1932x1932: 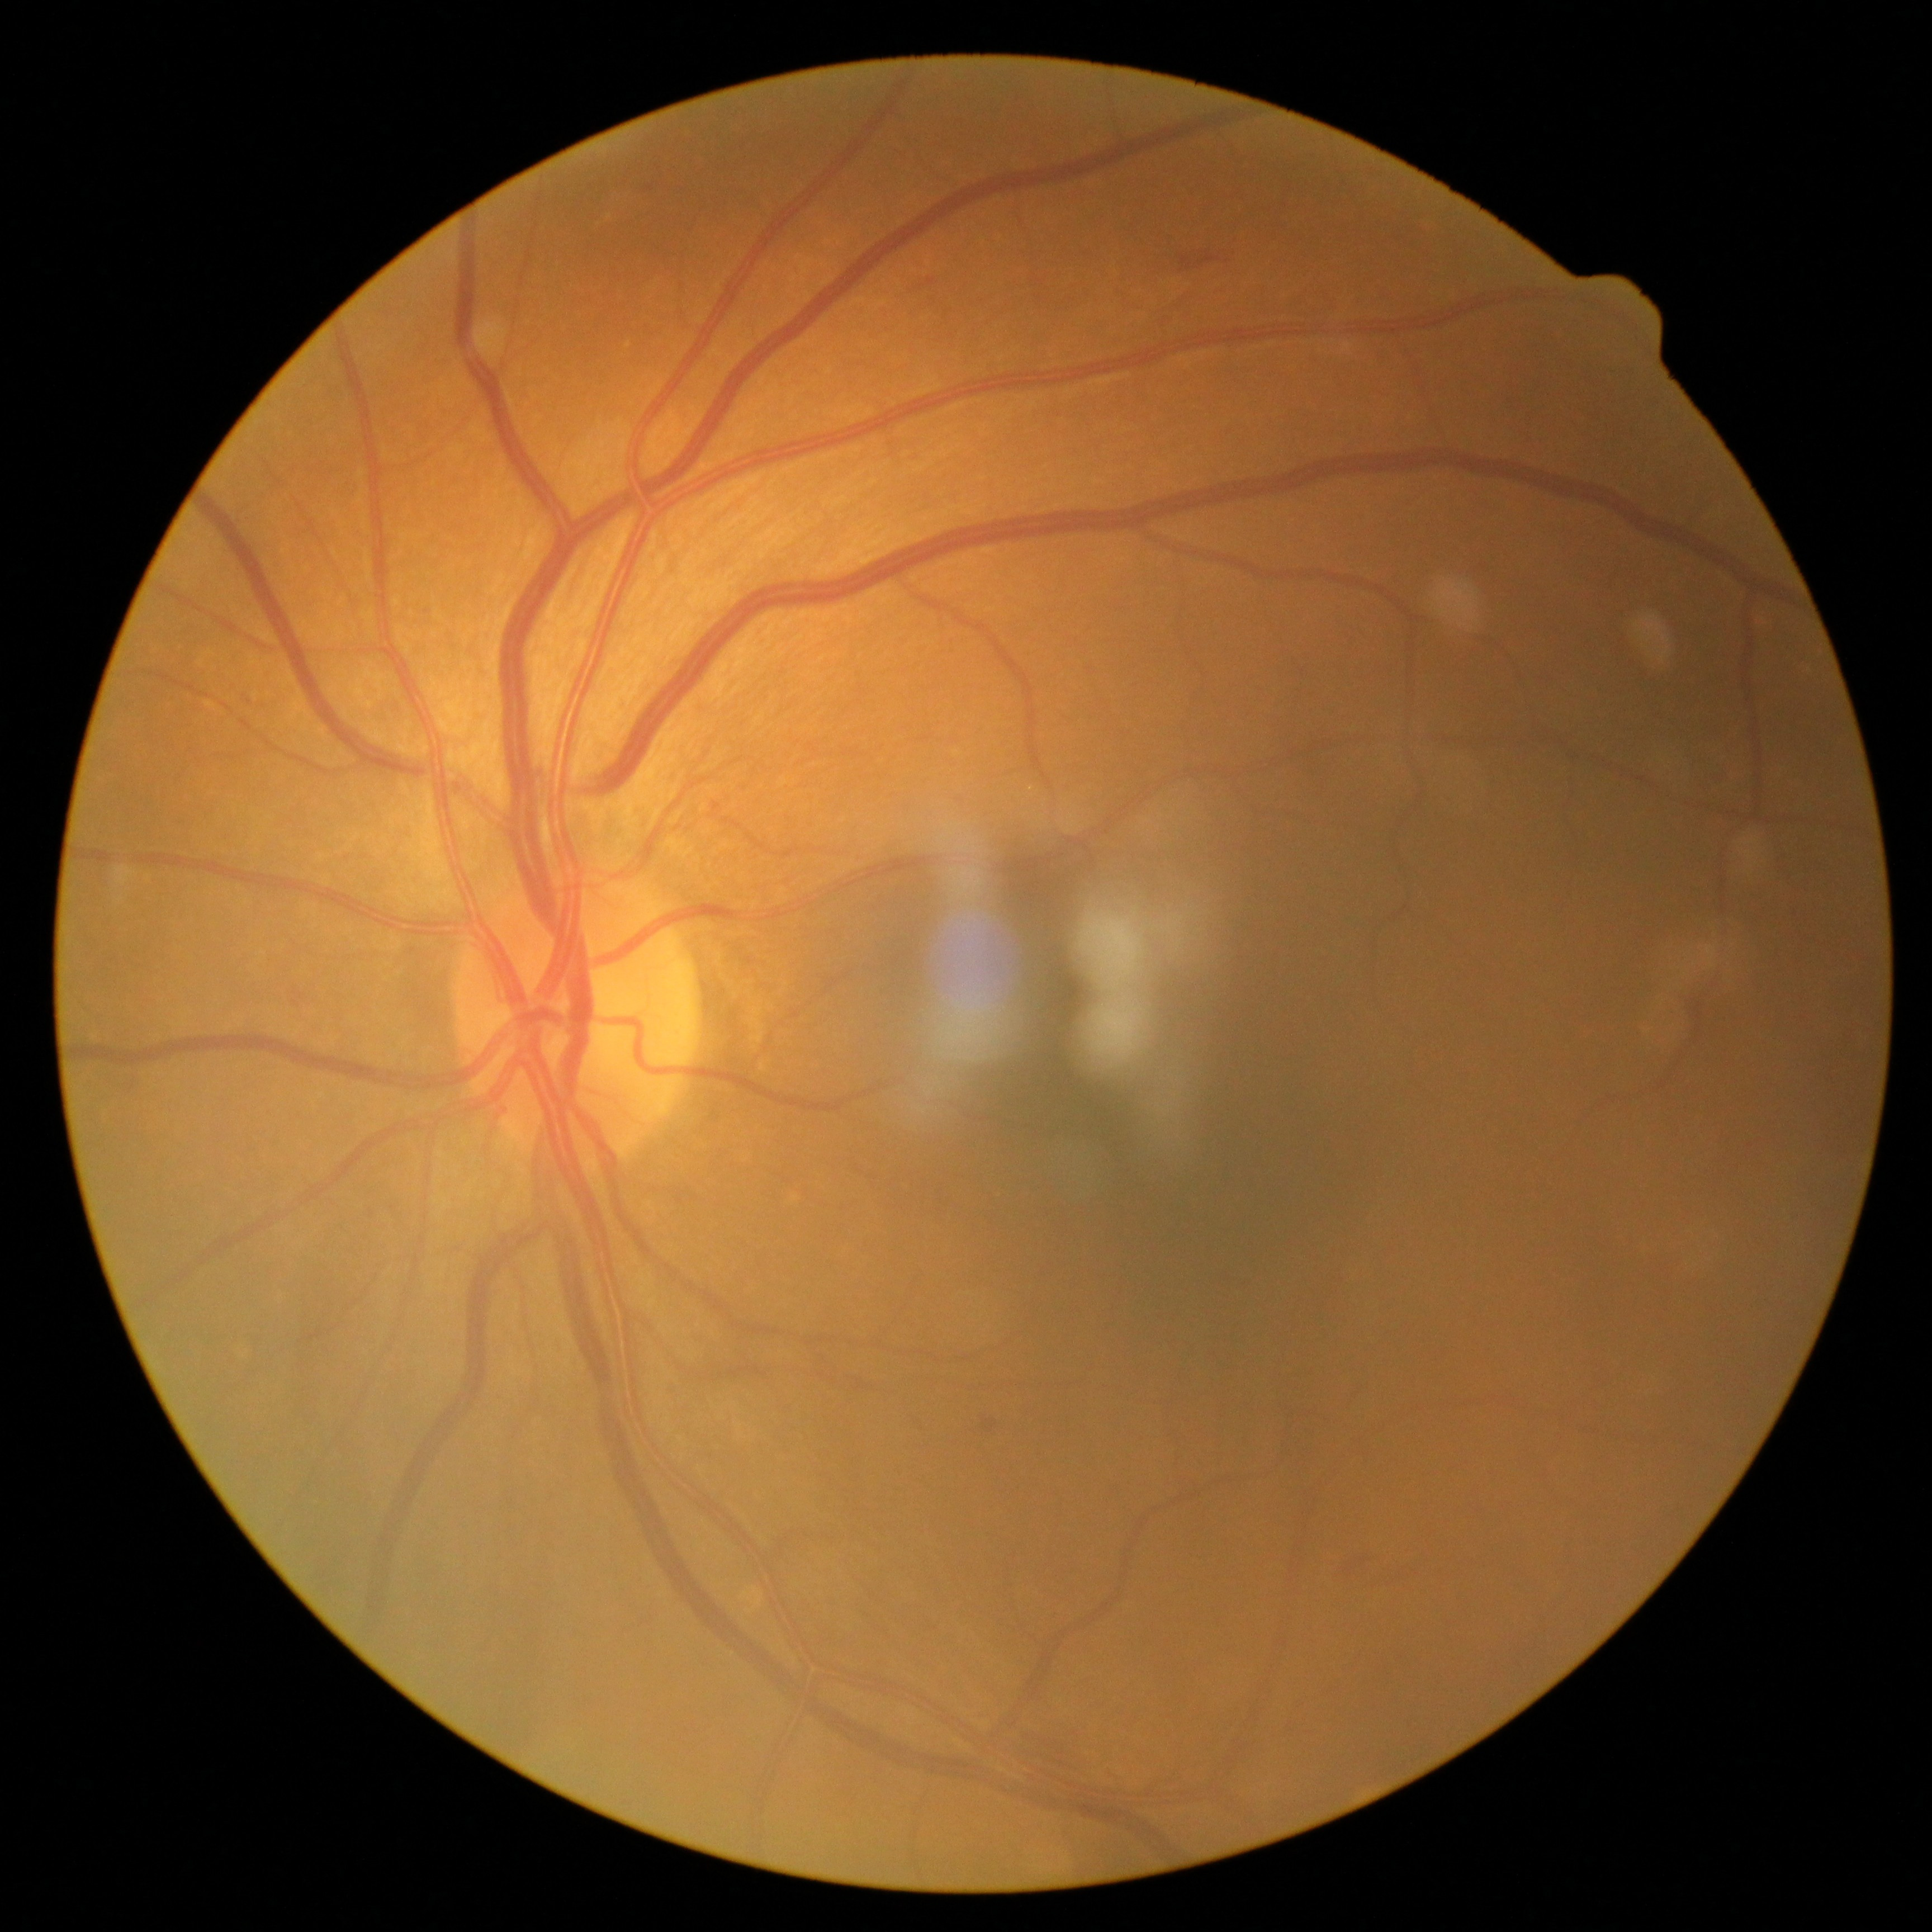 DR stage is moderate non-proliferative diabetic retinopathy (grade 2).